Infant wide-field retinal image
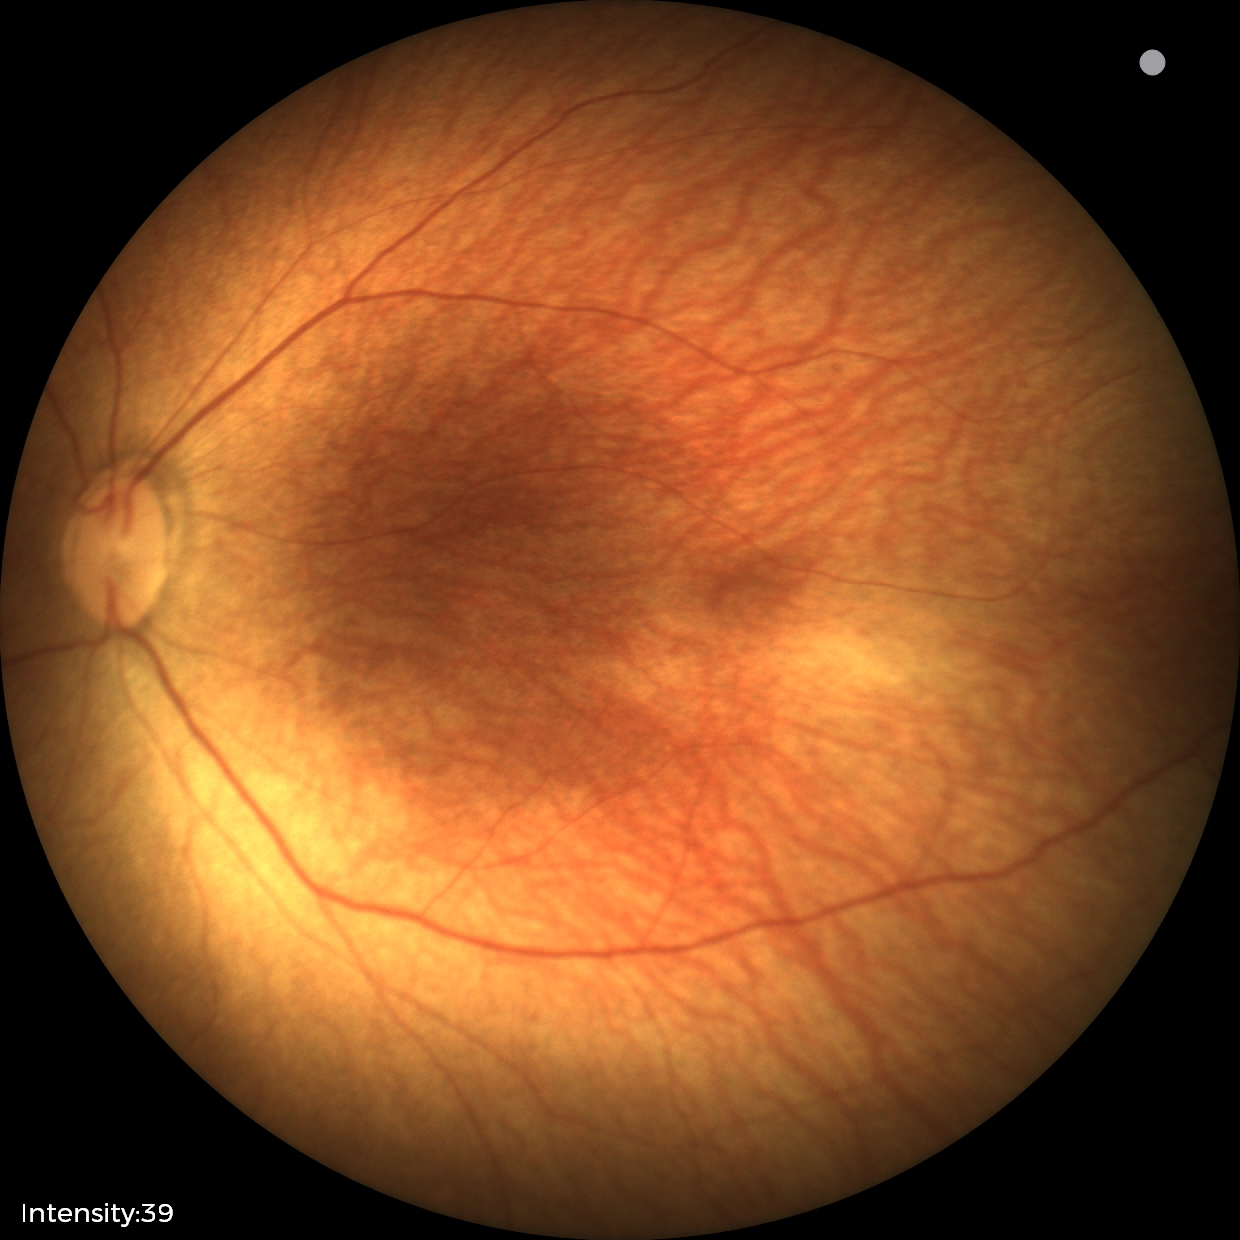 Normal screening examination.